Retinal fundus photograph:
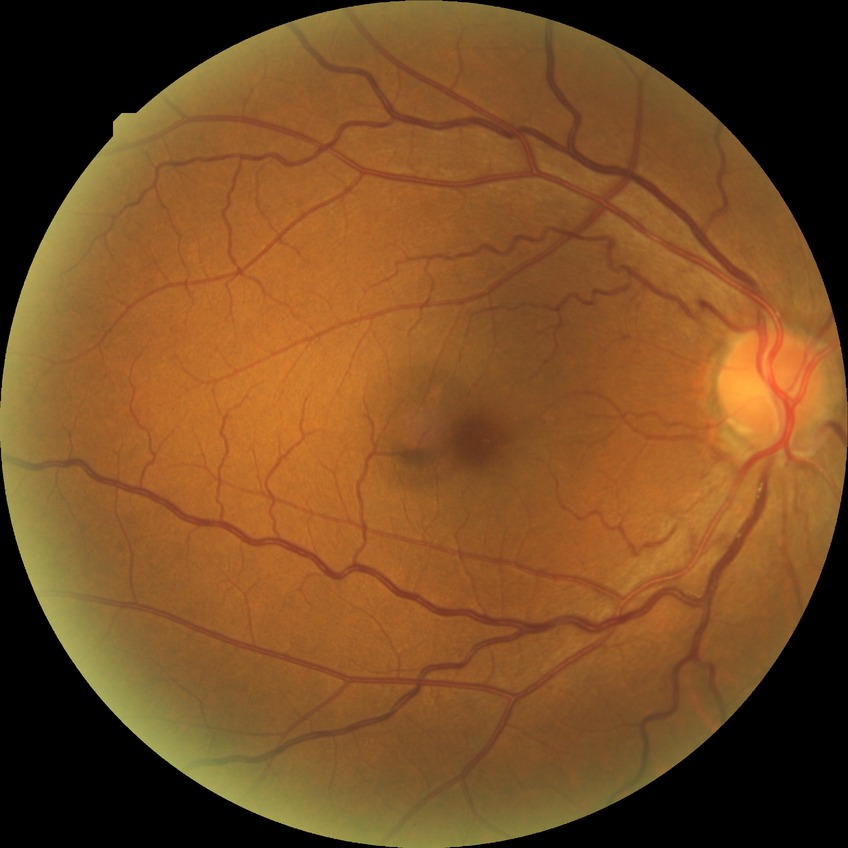 {
  "davis_grade": "NDR"
}